50° FOV. Central posterior field. Mydriatic (tropicamide and phenylephrine). 2228 x 1652 pixels. Color fundus image — 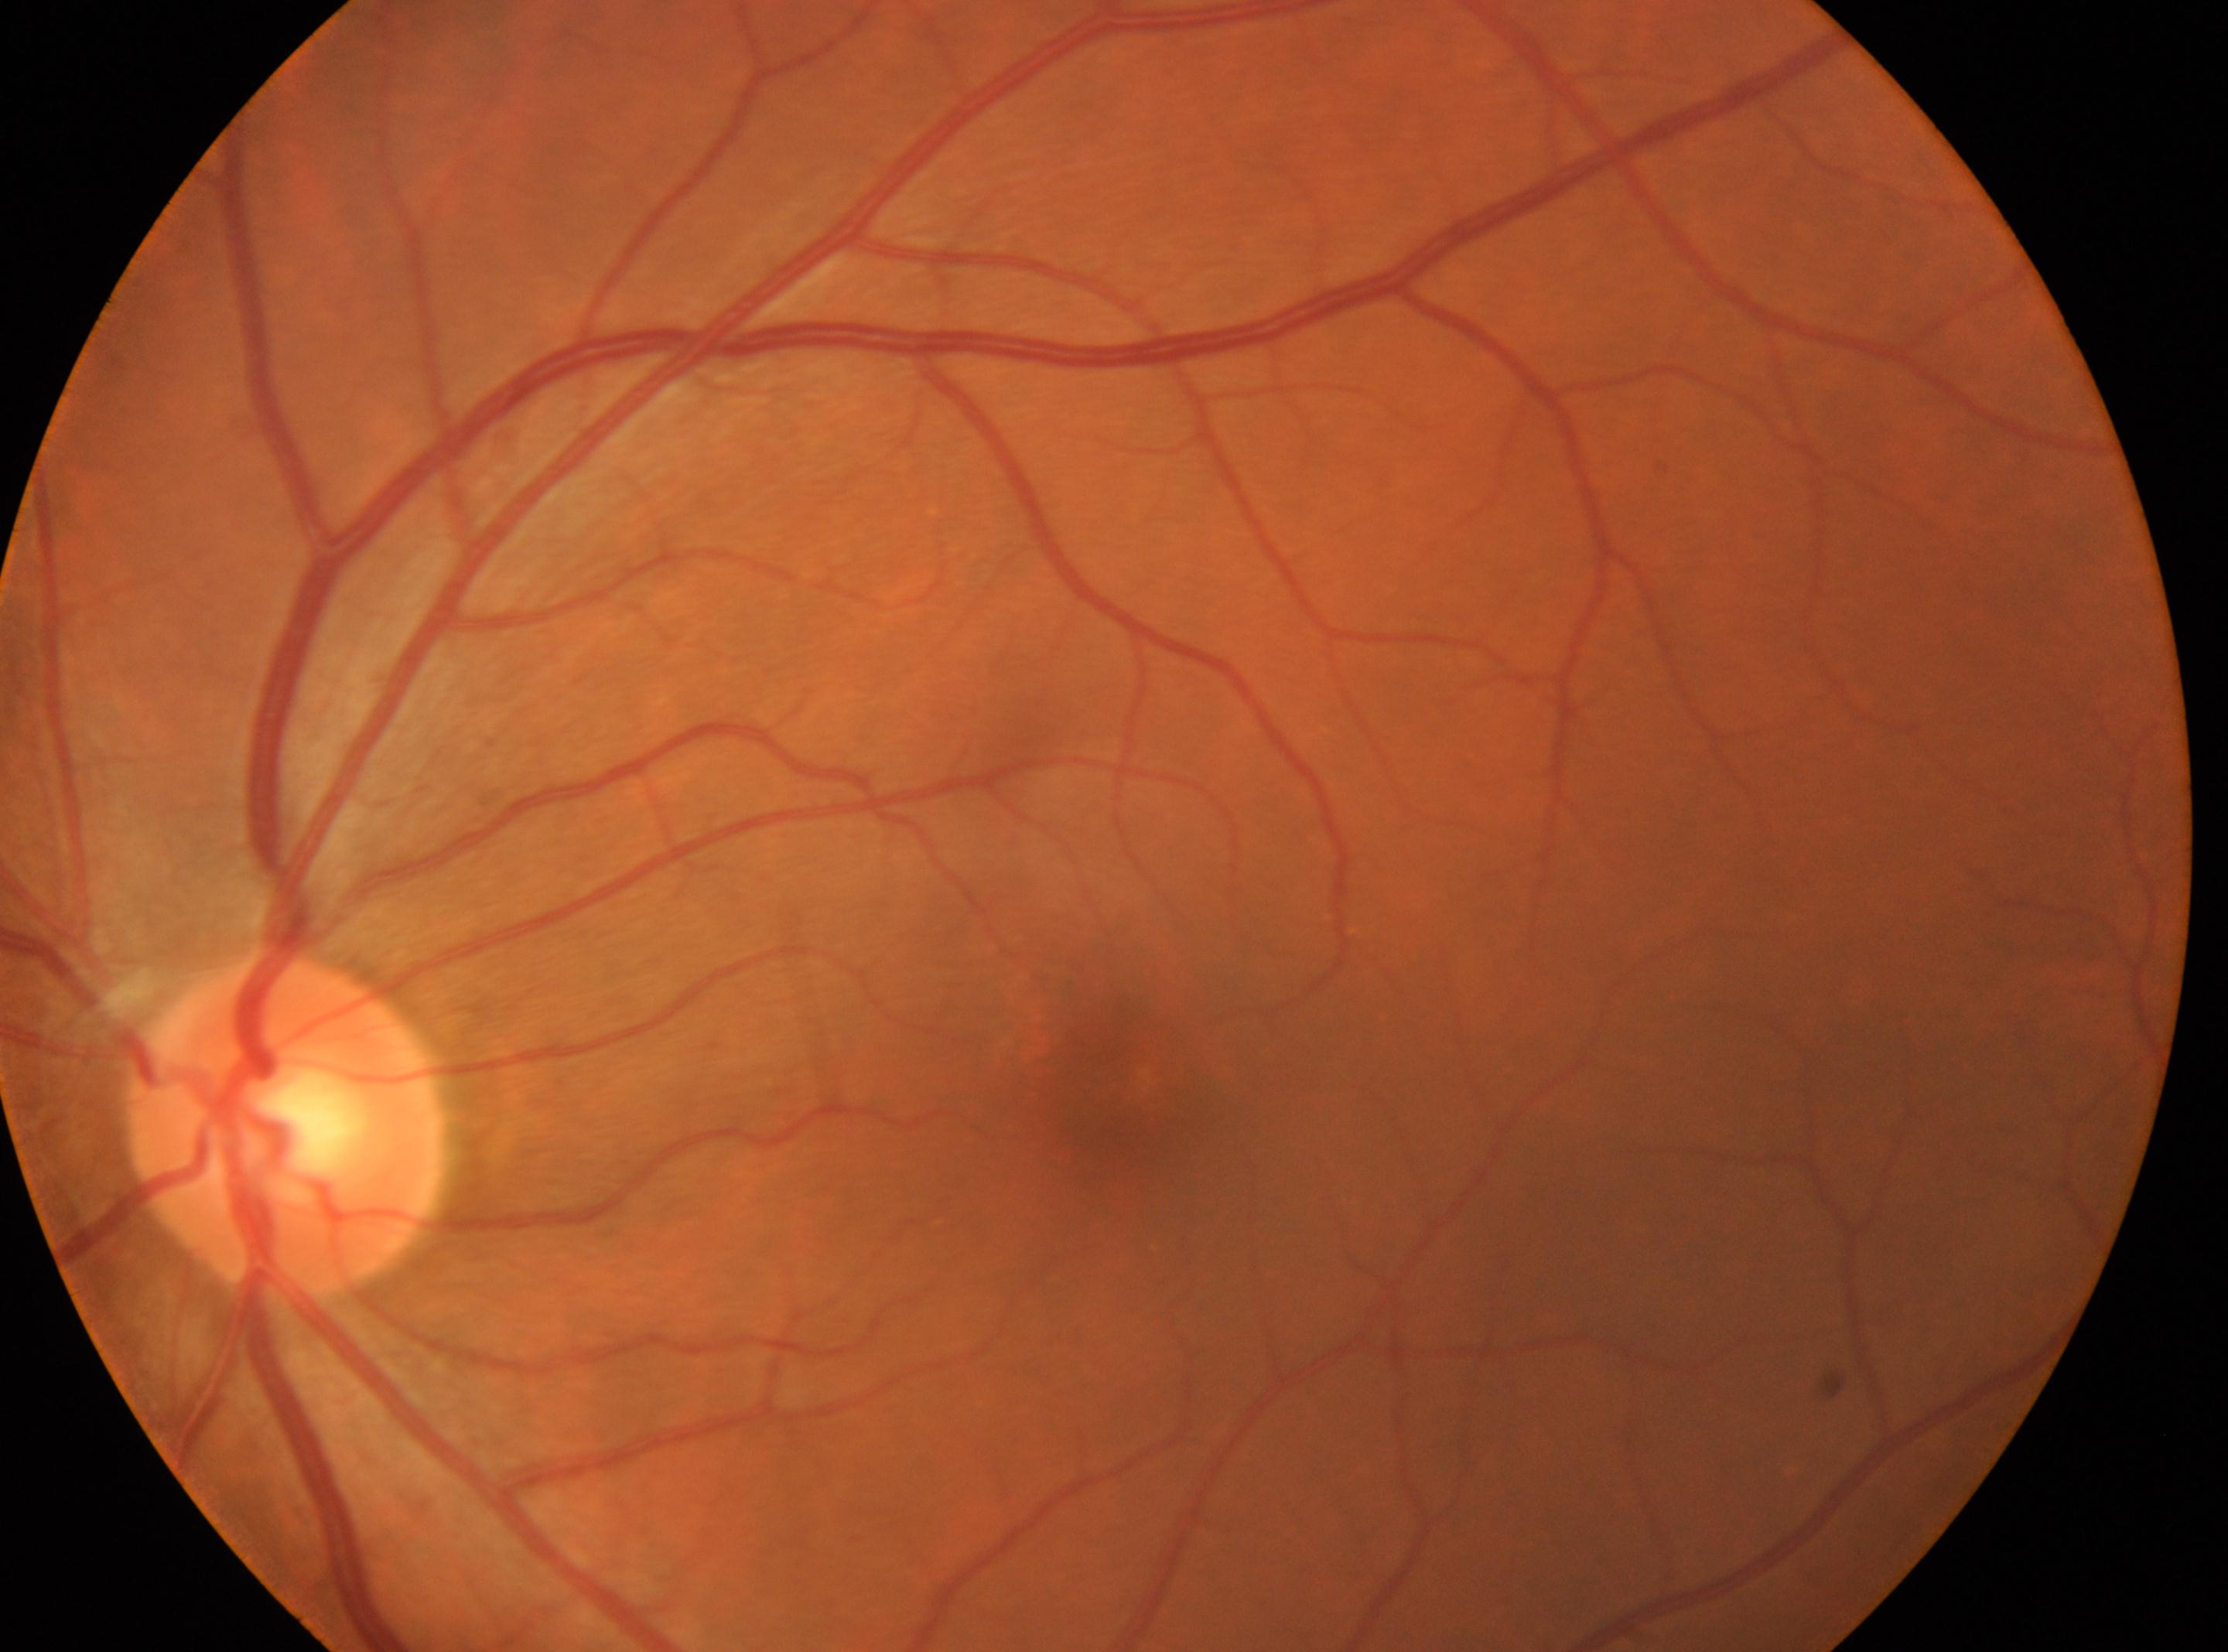
{"optic_disc": "(x=282, y=1122)", "dr_grade": "0", "fovea": "(x=1114, y=1086)", "eye": "left"}